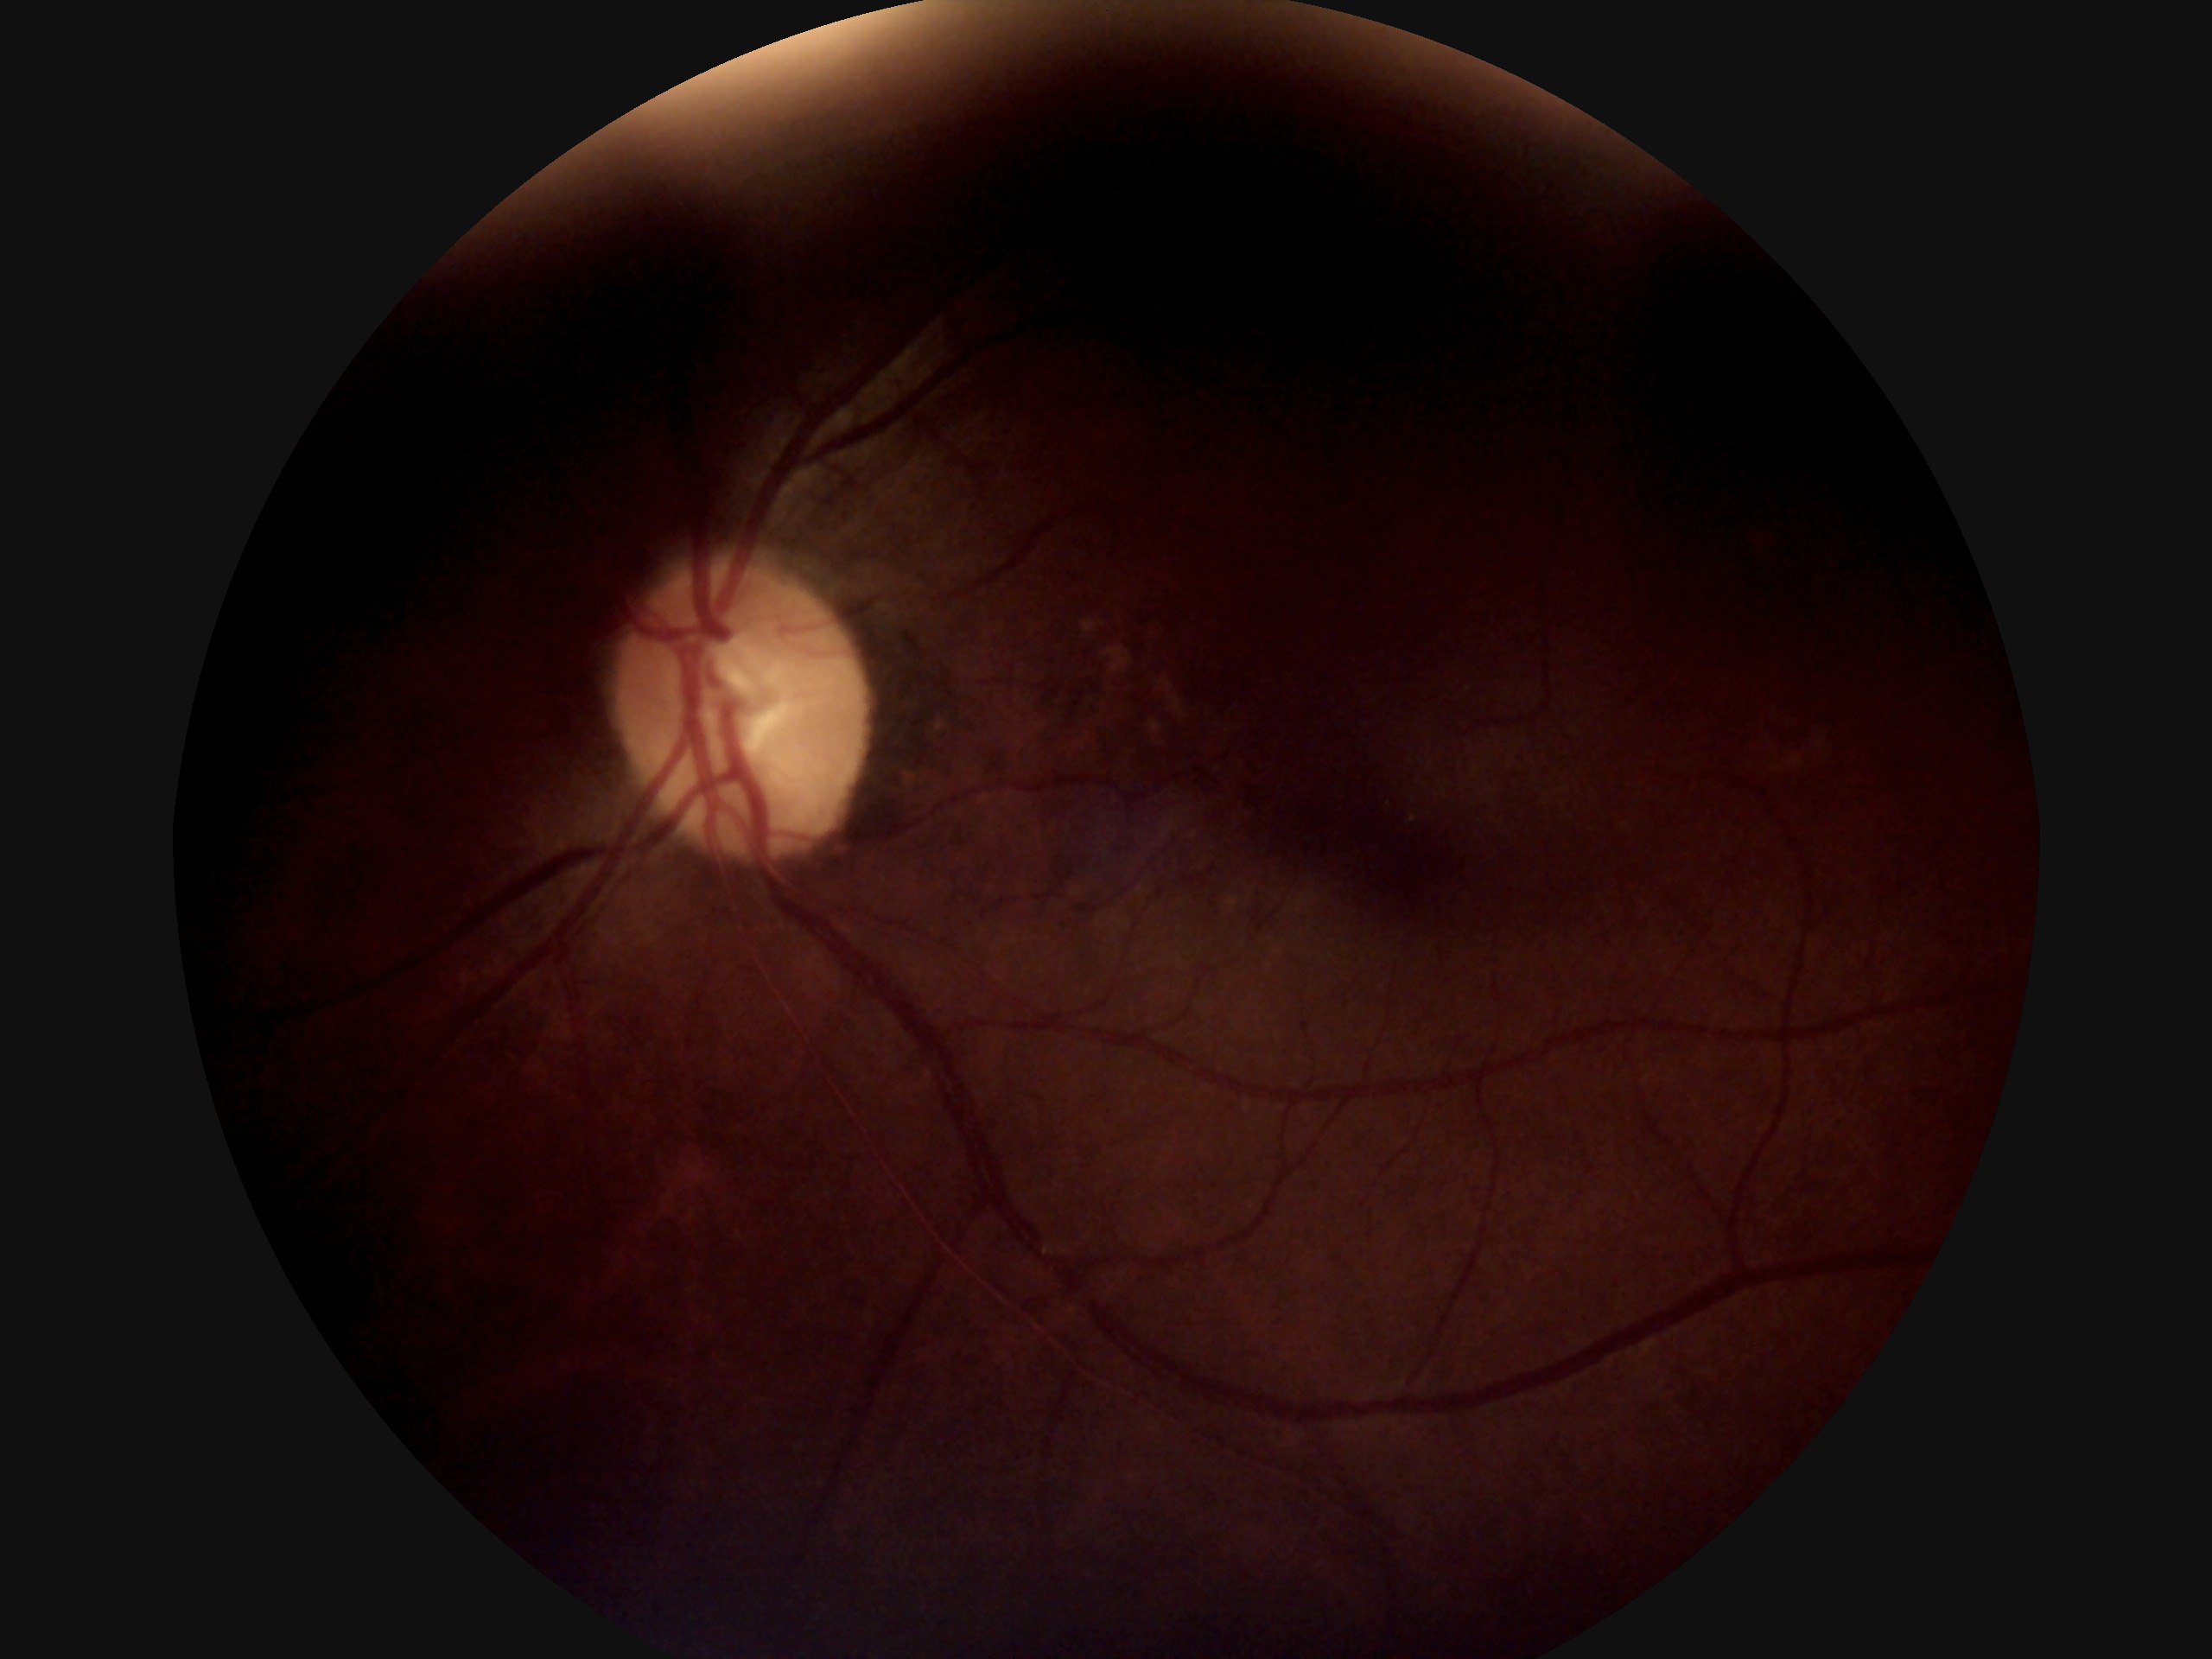

Diabetic retinopathy (DR) is grade 0 (no apparent retinopathy).